Retinal fundus photograph
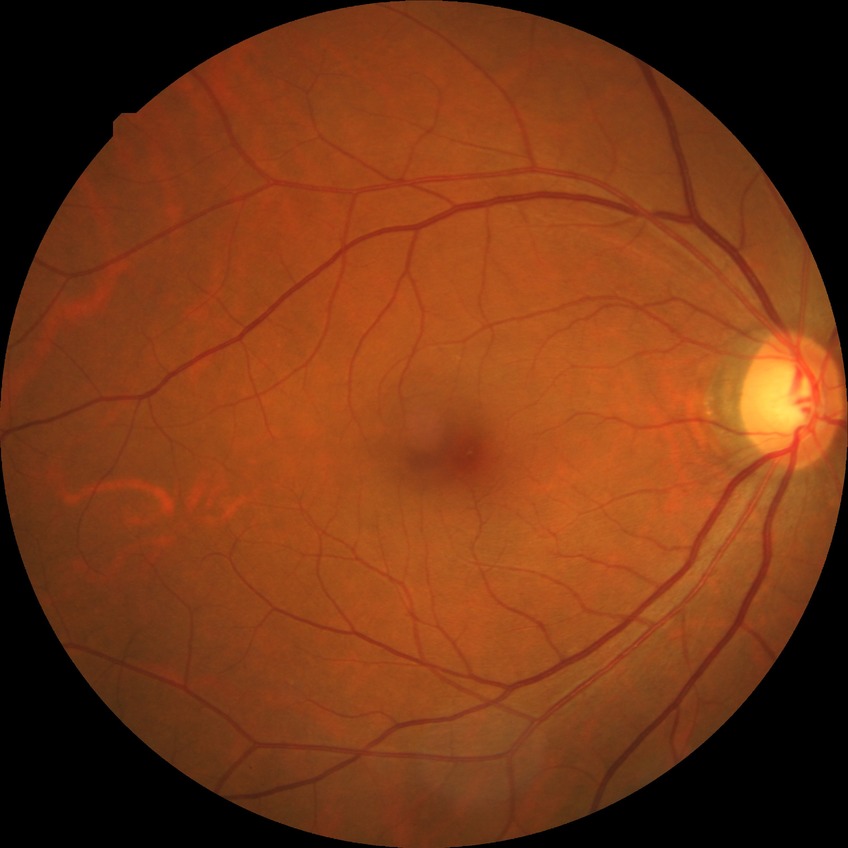 {"dr_impression": "no apparent DR", "davis_grade": "NDR"}